Pupil-dilated — 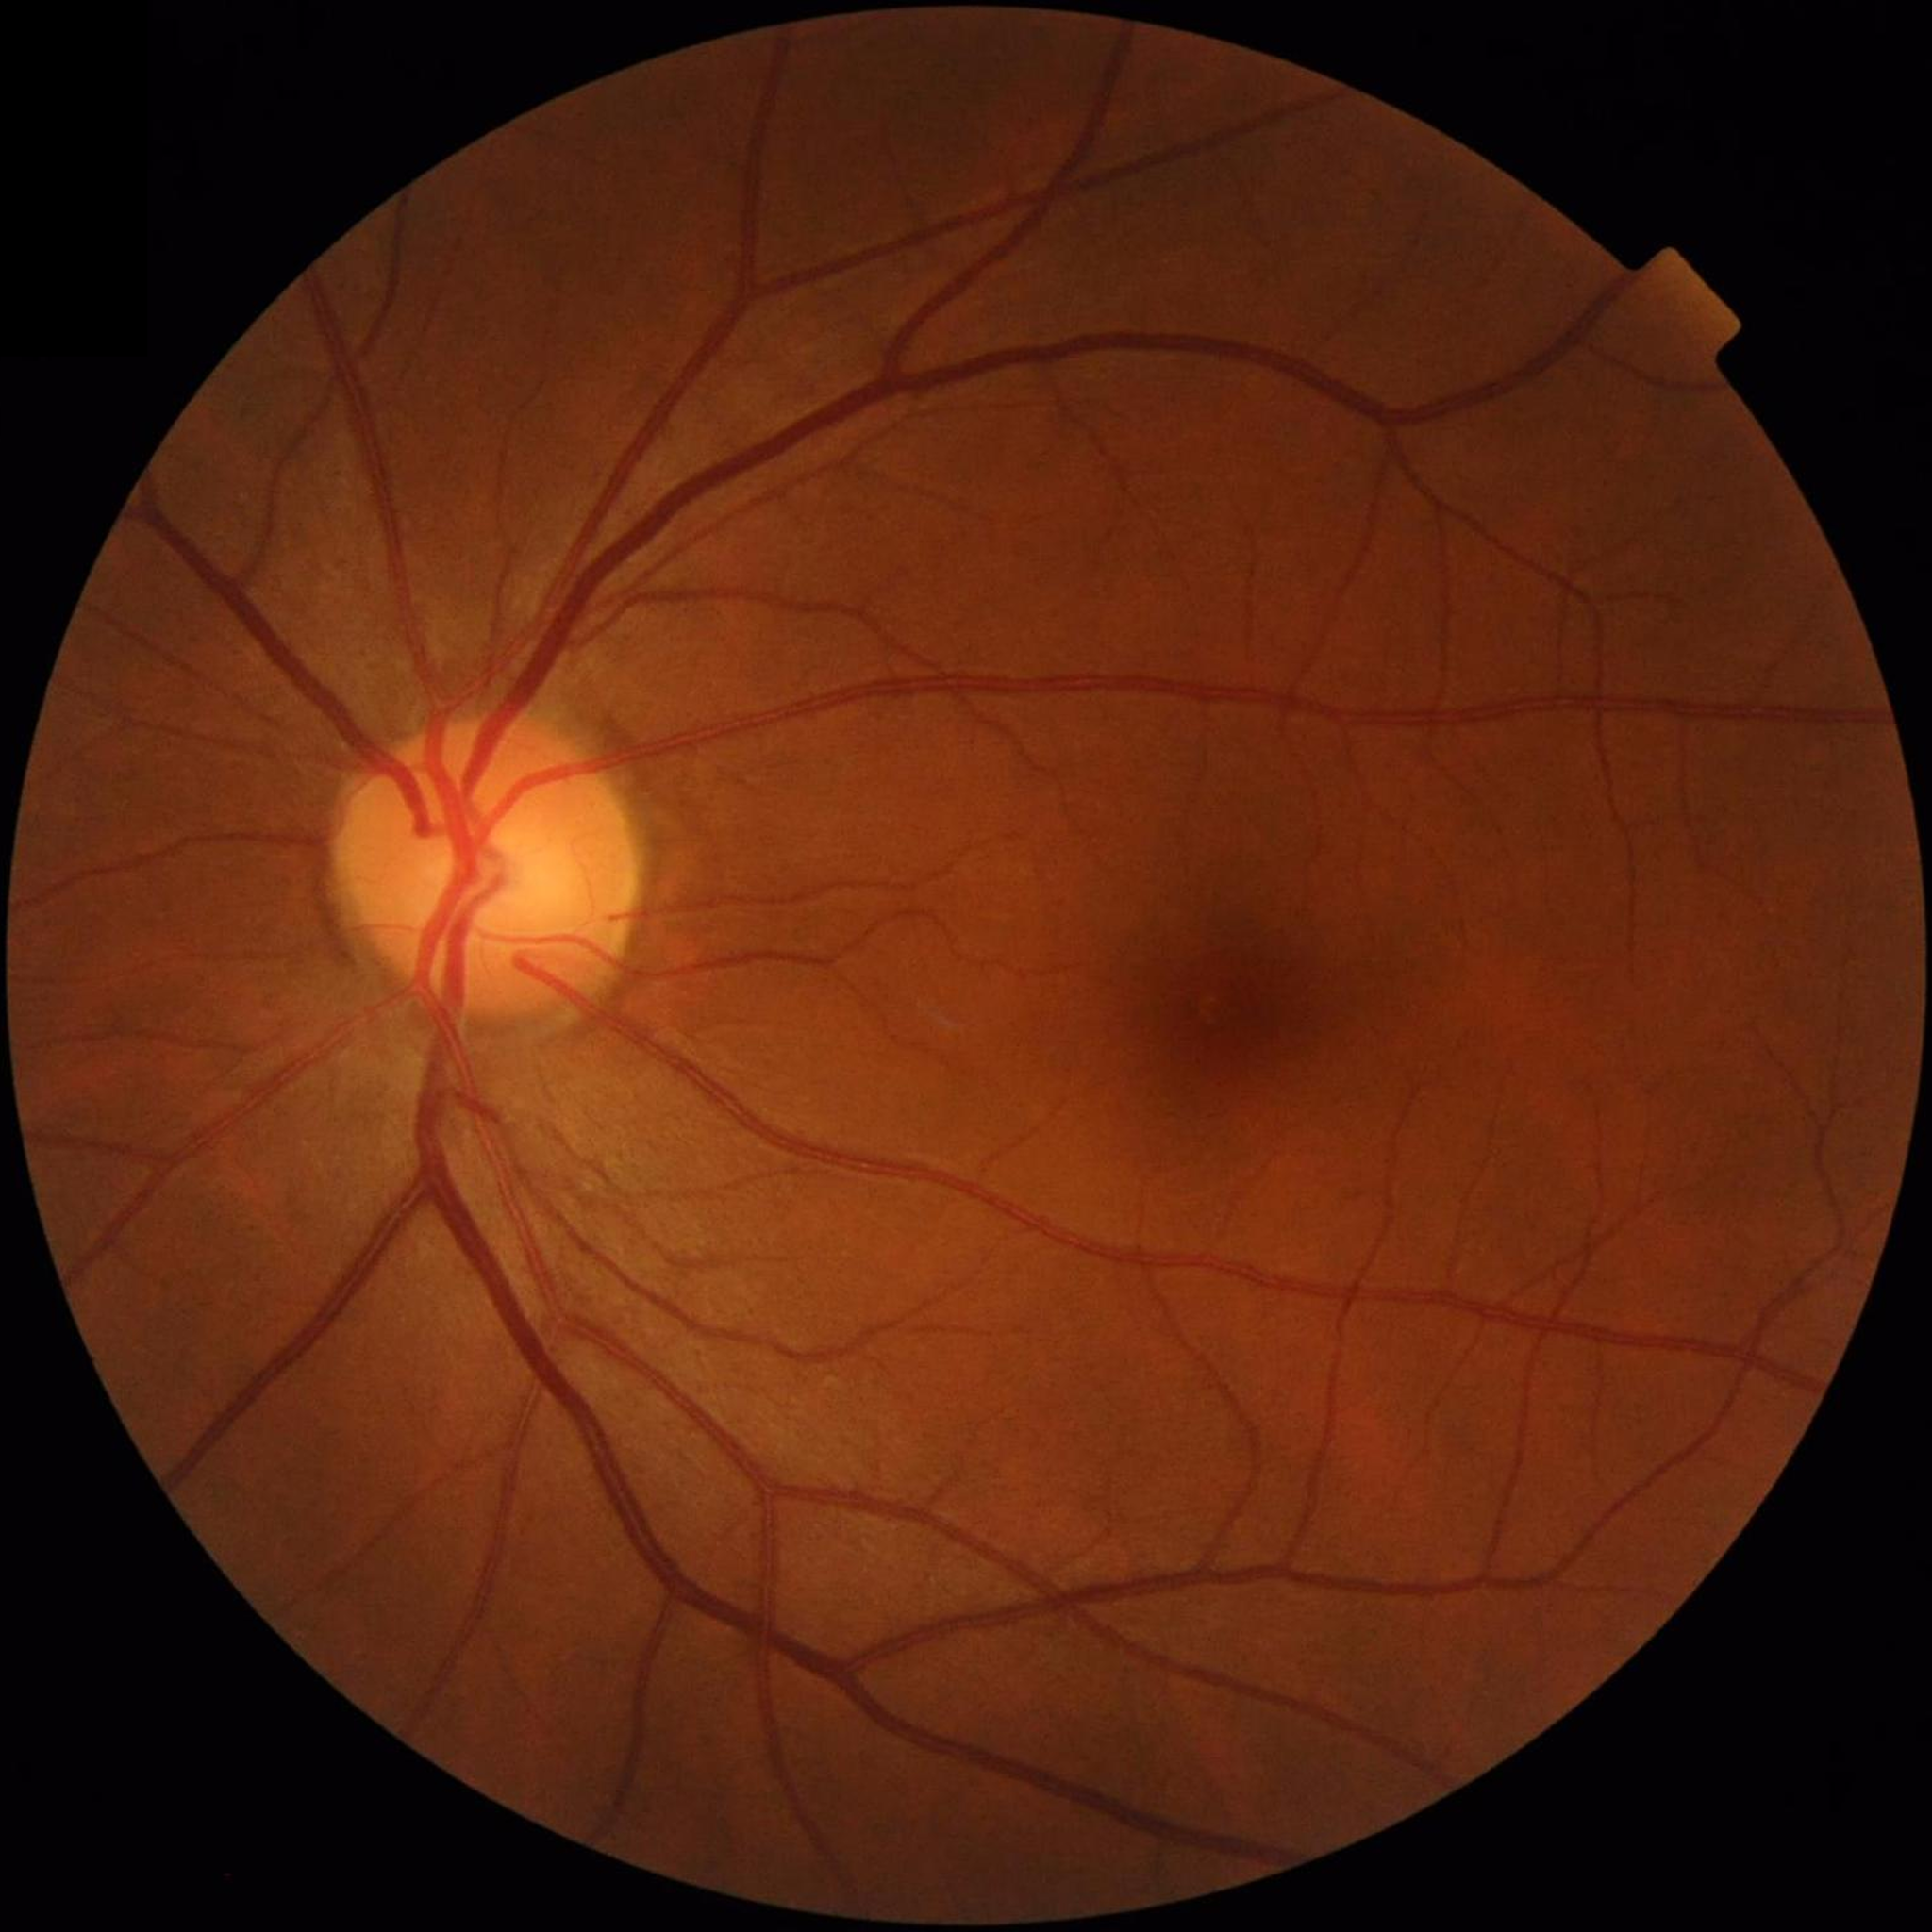 Quality assessment: no concerns identified
Disease class: no AMD, DR, or glaucomatous findings